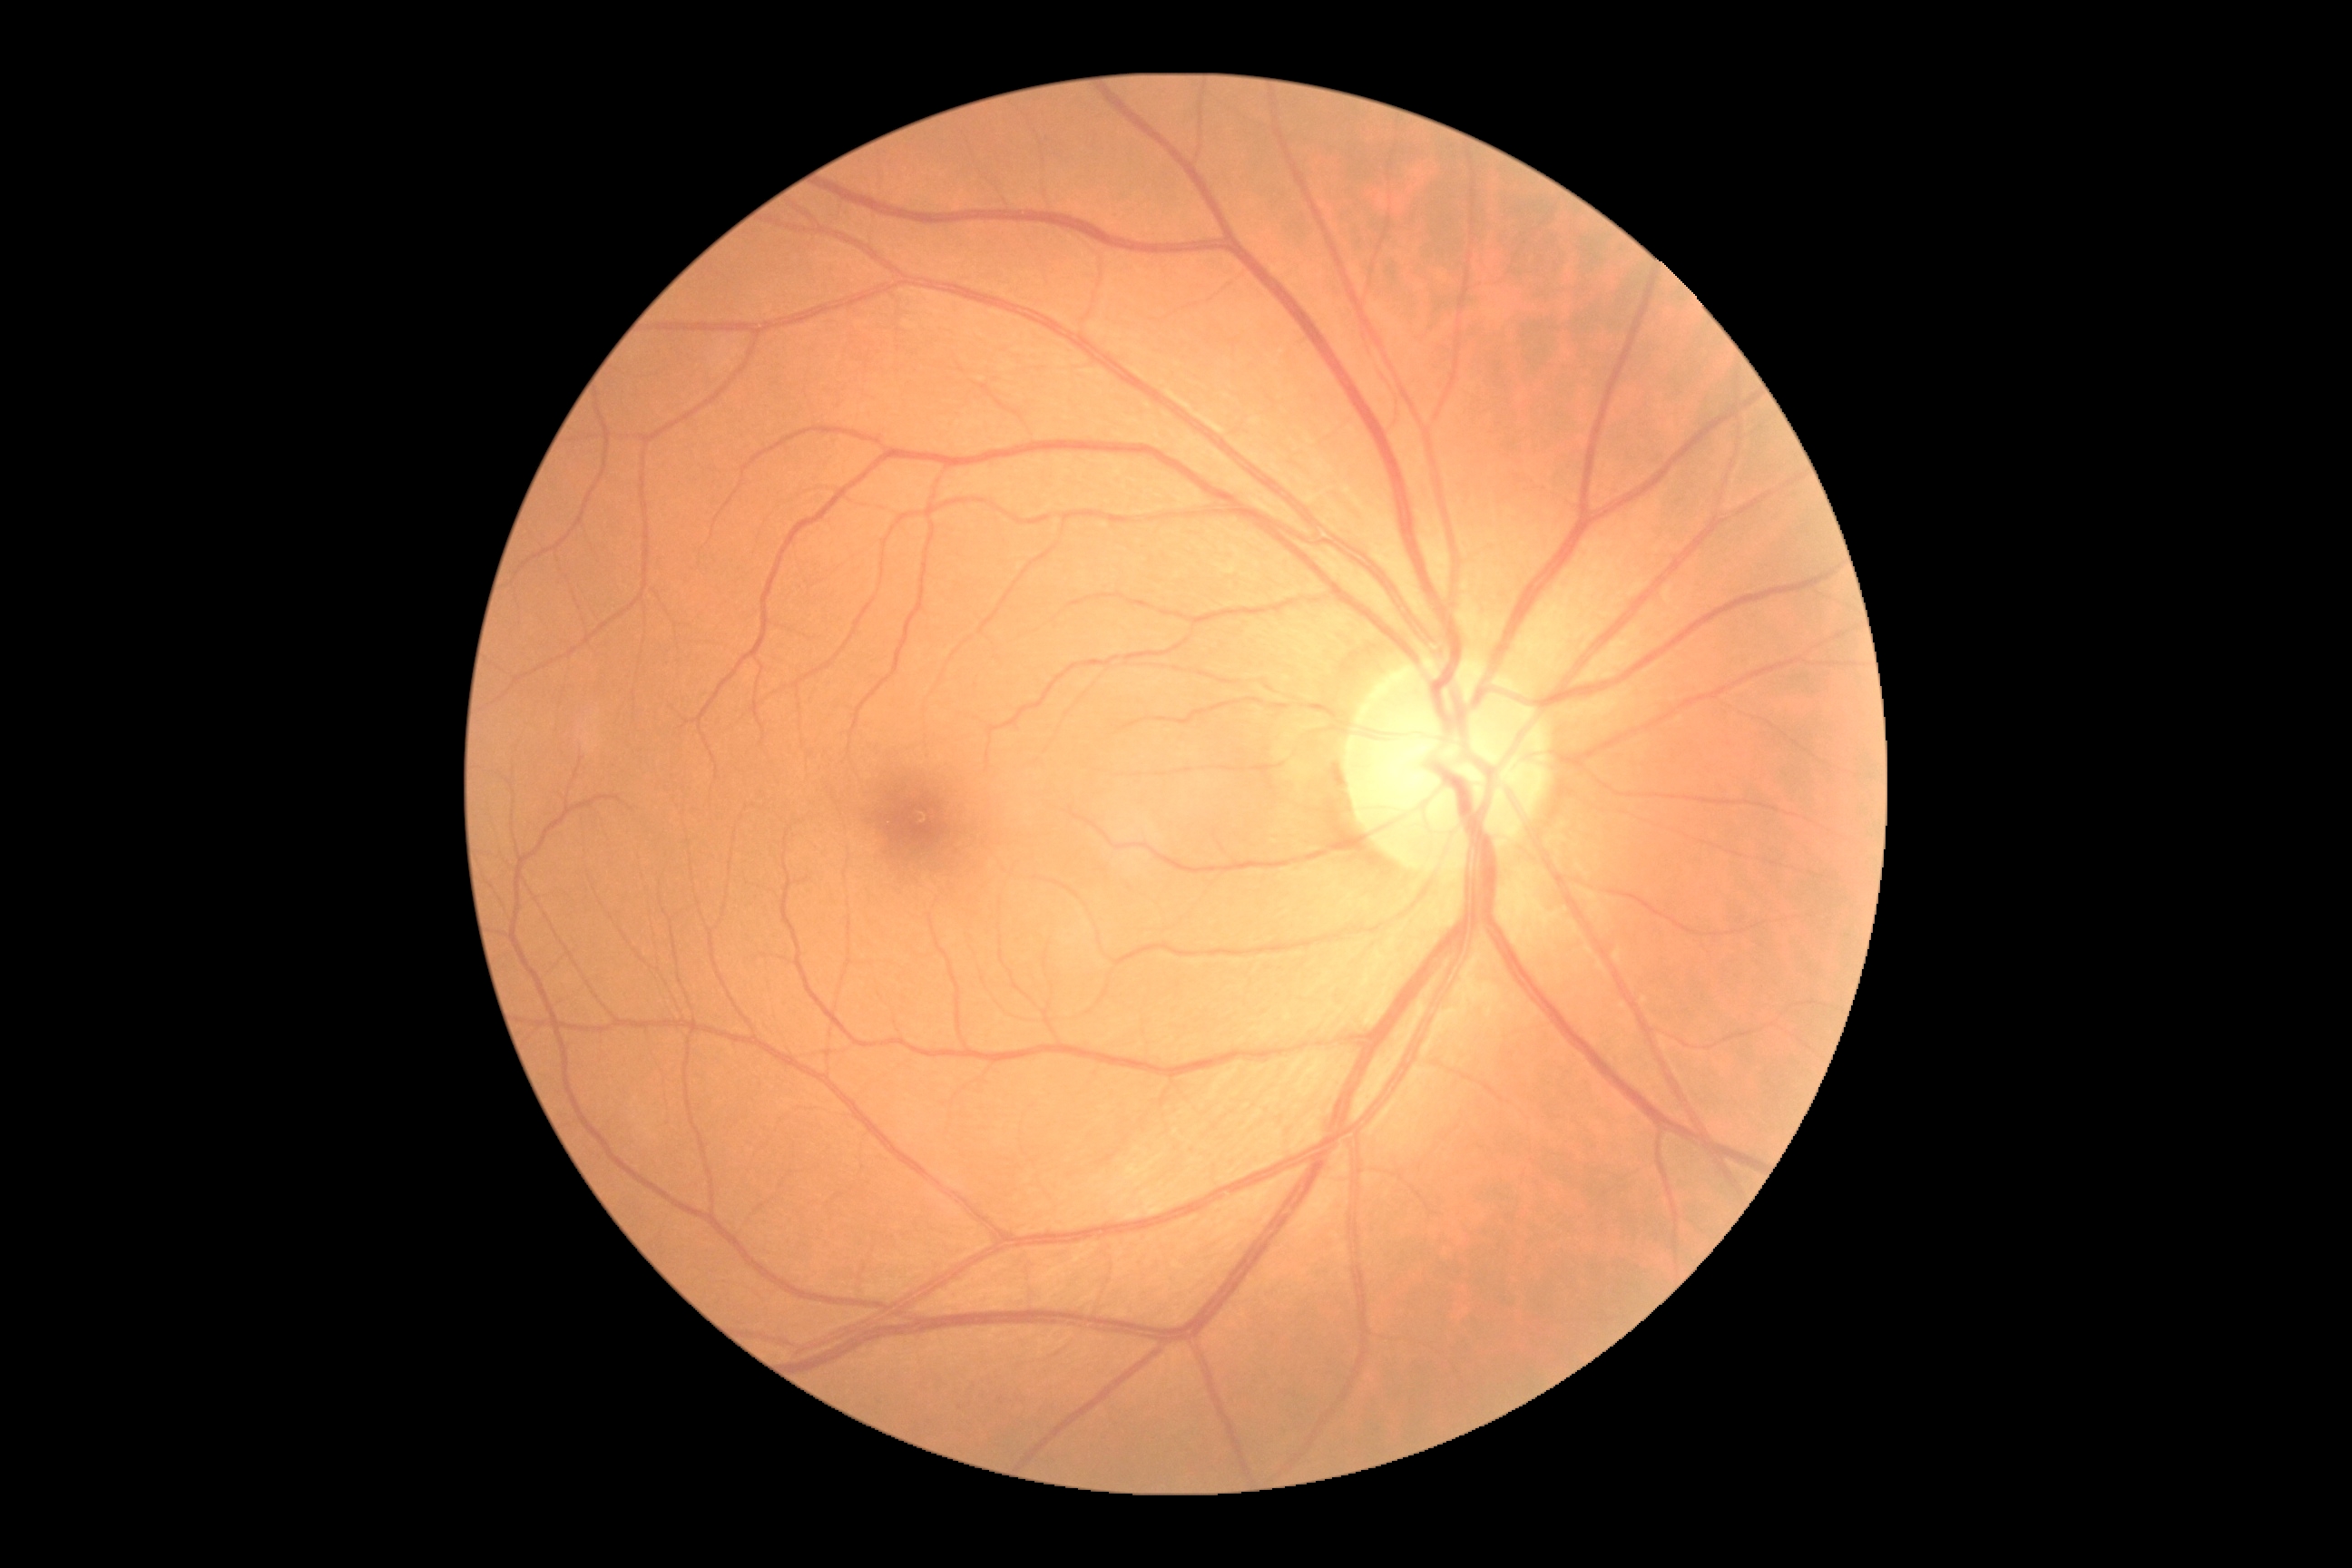

DR stage is grade 0 (no apparent retinopathy).